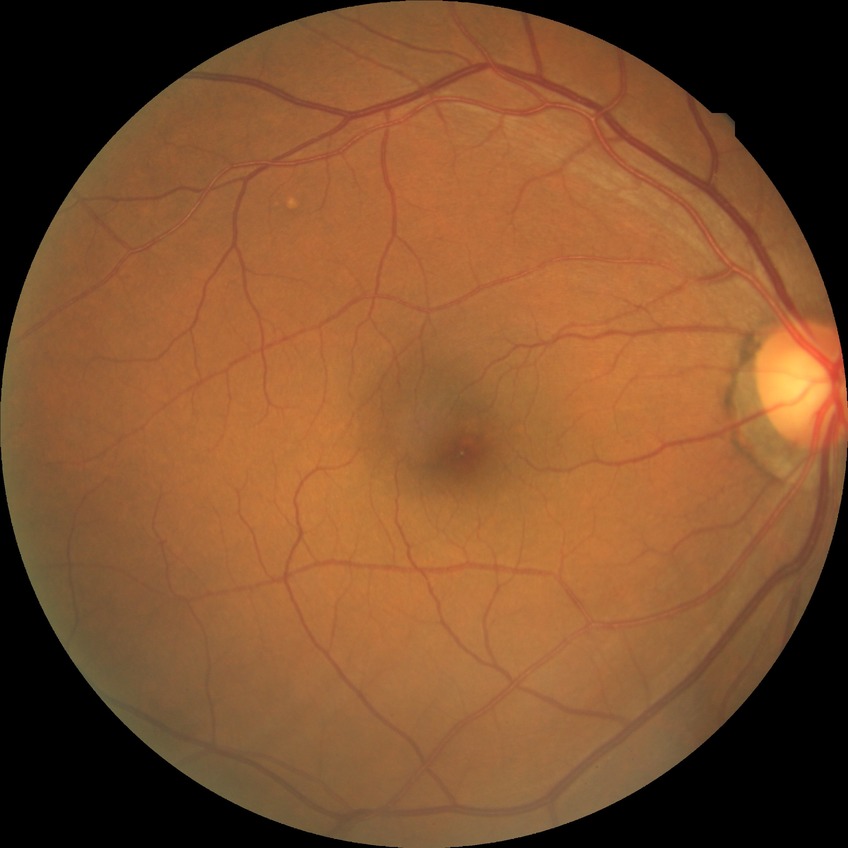
Diabetic retinopathy (DR): NDR (no diabetic retinopathy).